FOV: 45 degrees
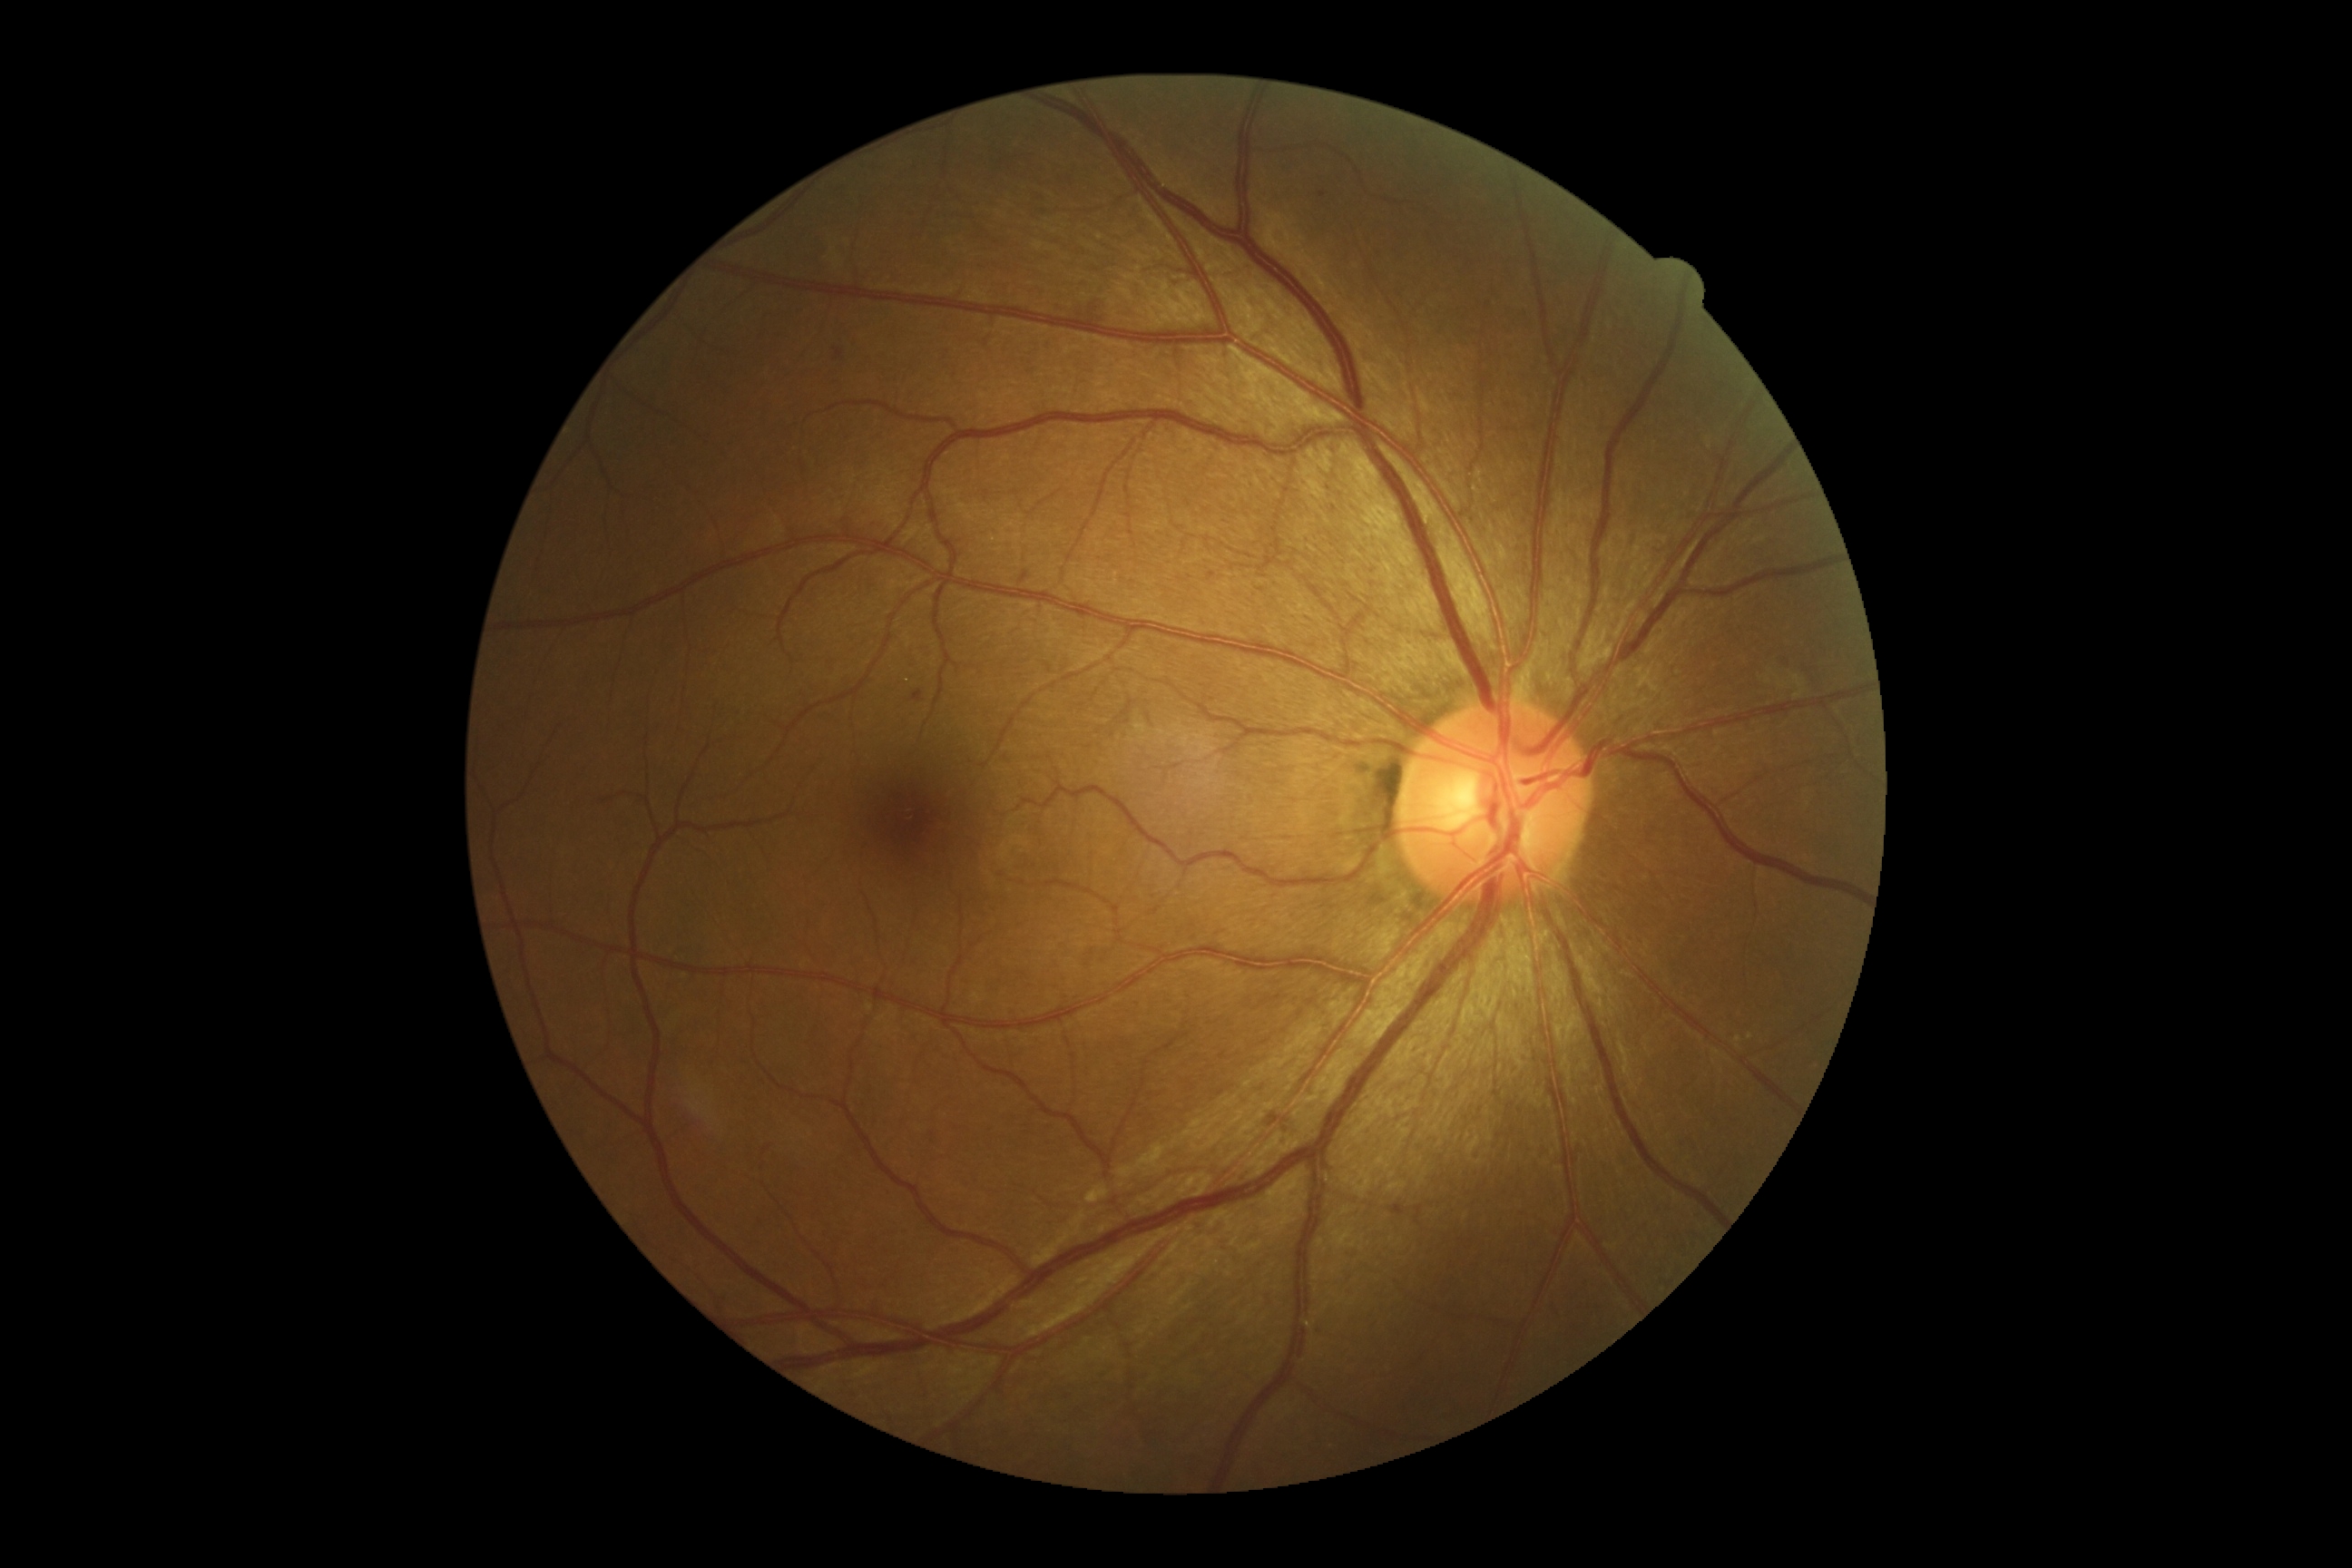
diabetic retinopathy (DR): grade 2 (moderate NPDR).